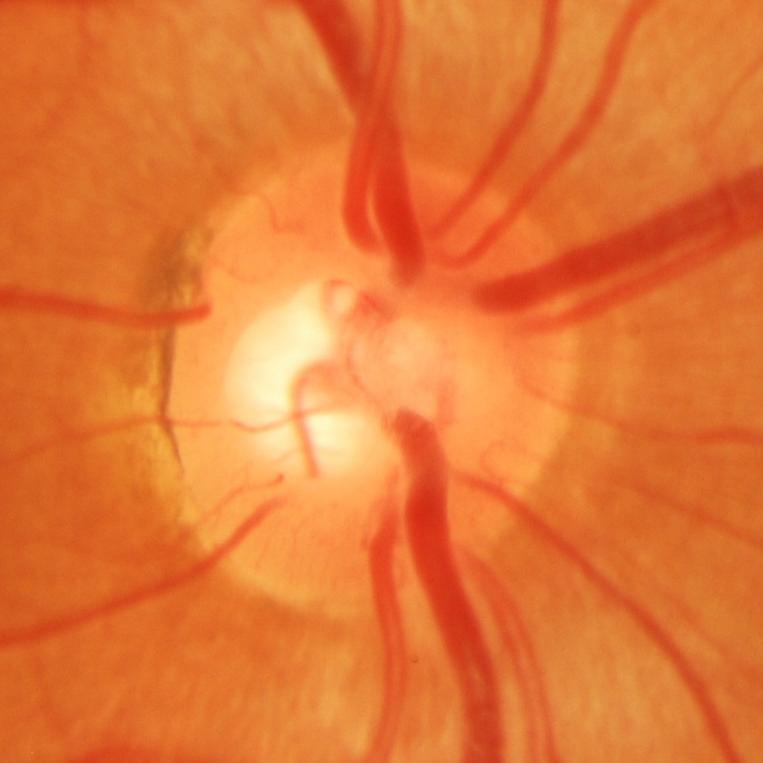
Showing glaucomatous changes.